Image size 2352x1568 — 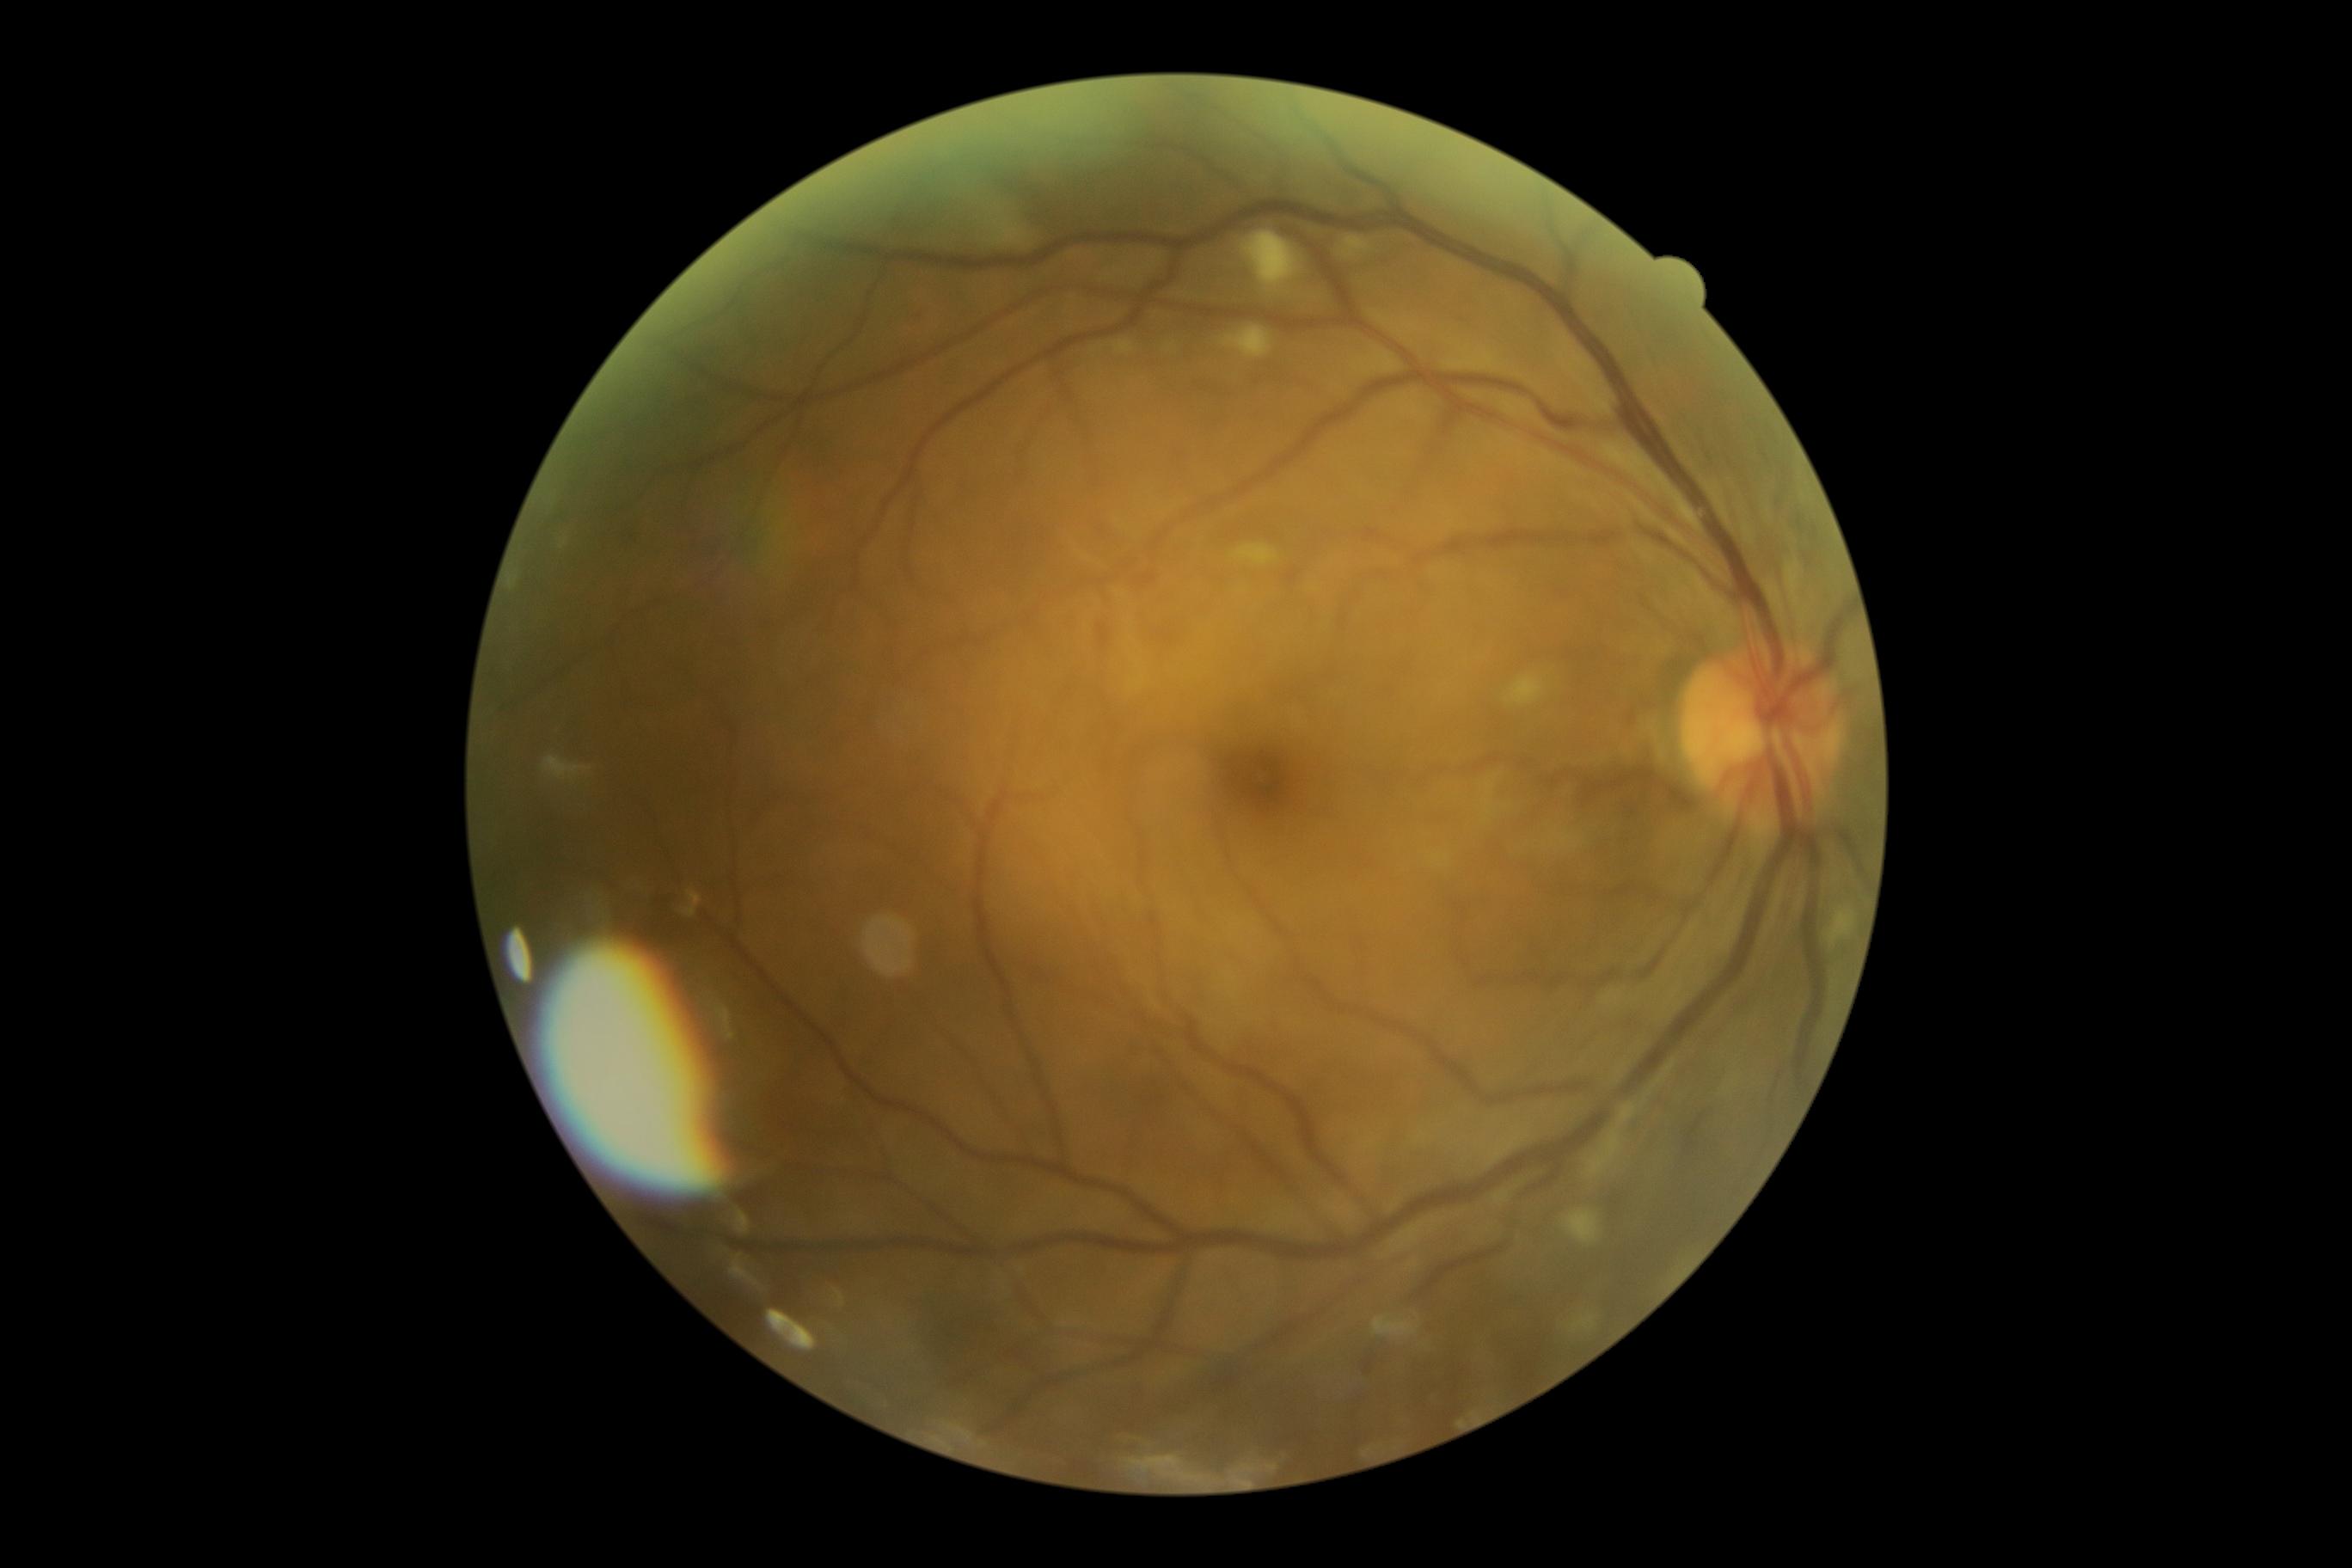

DR class = non-proliferative diabetic retinopathy | DR severity = grade 2 (moderate NPDR).